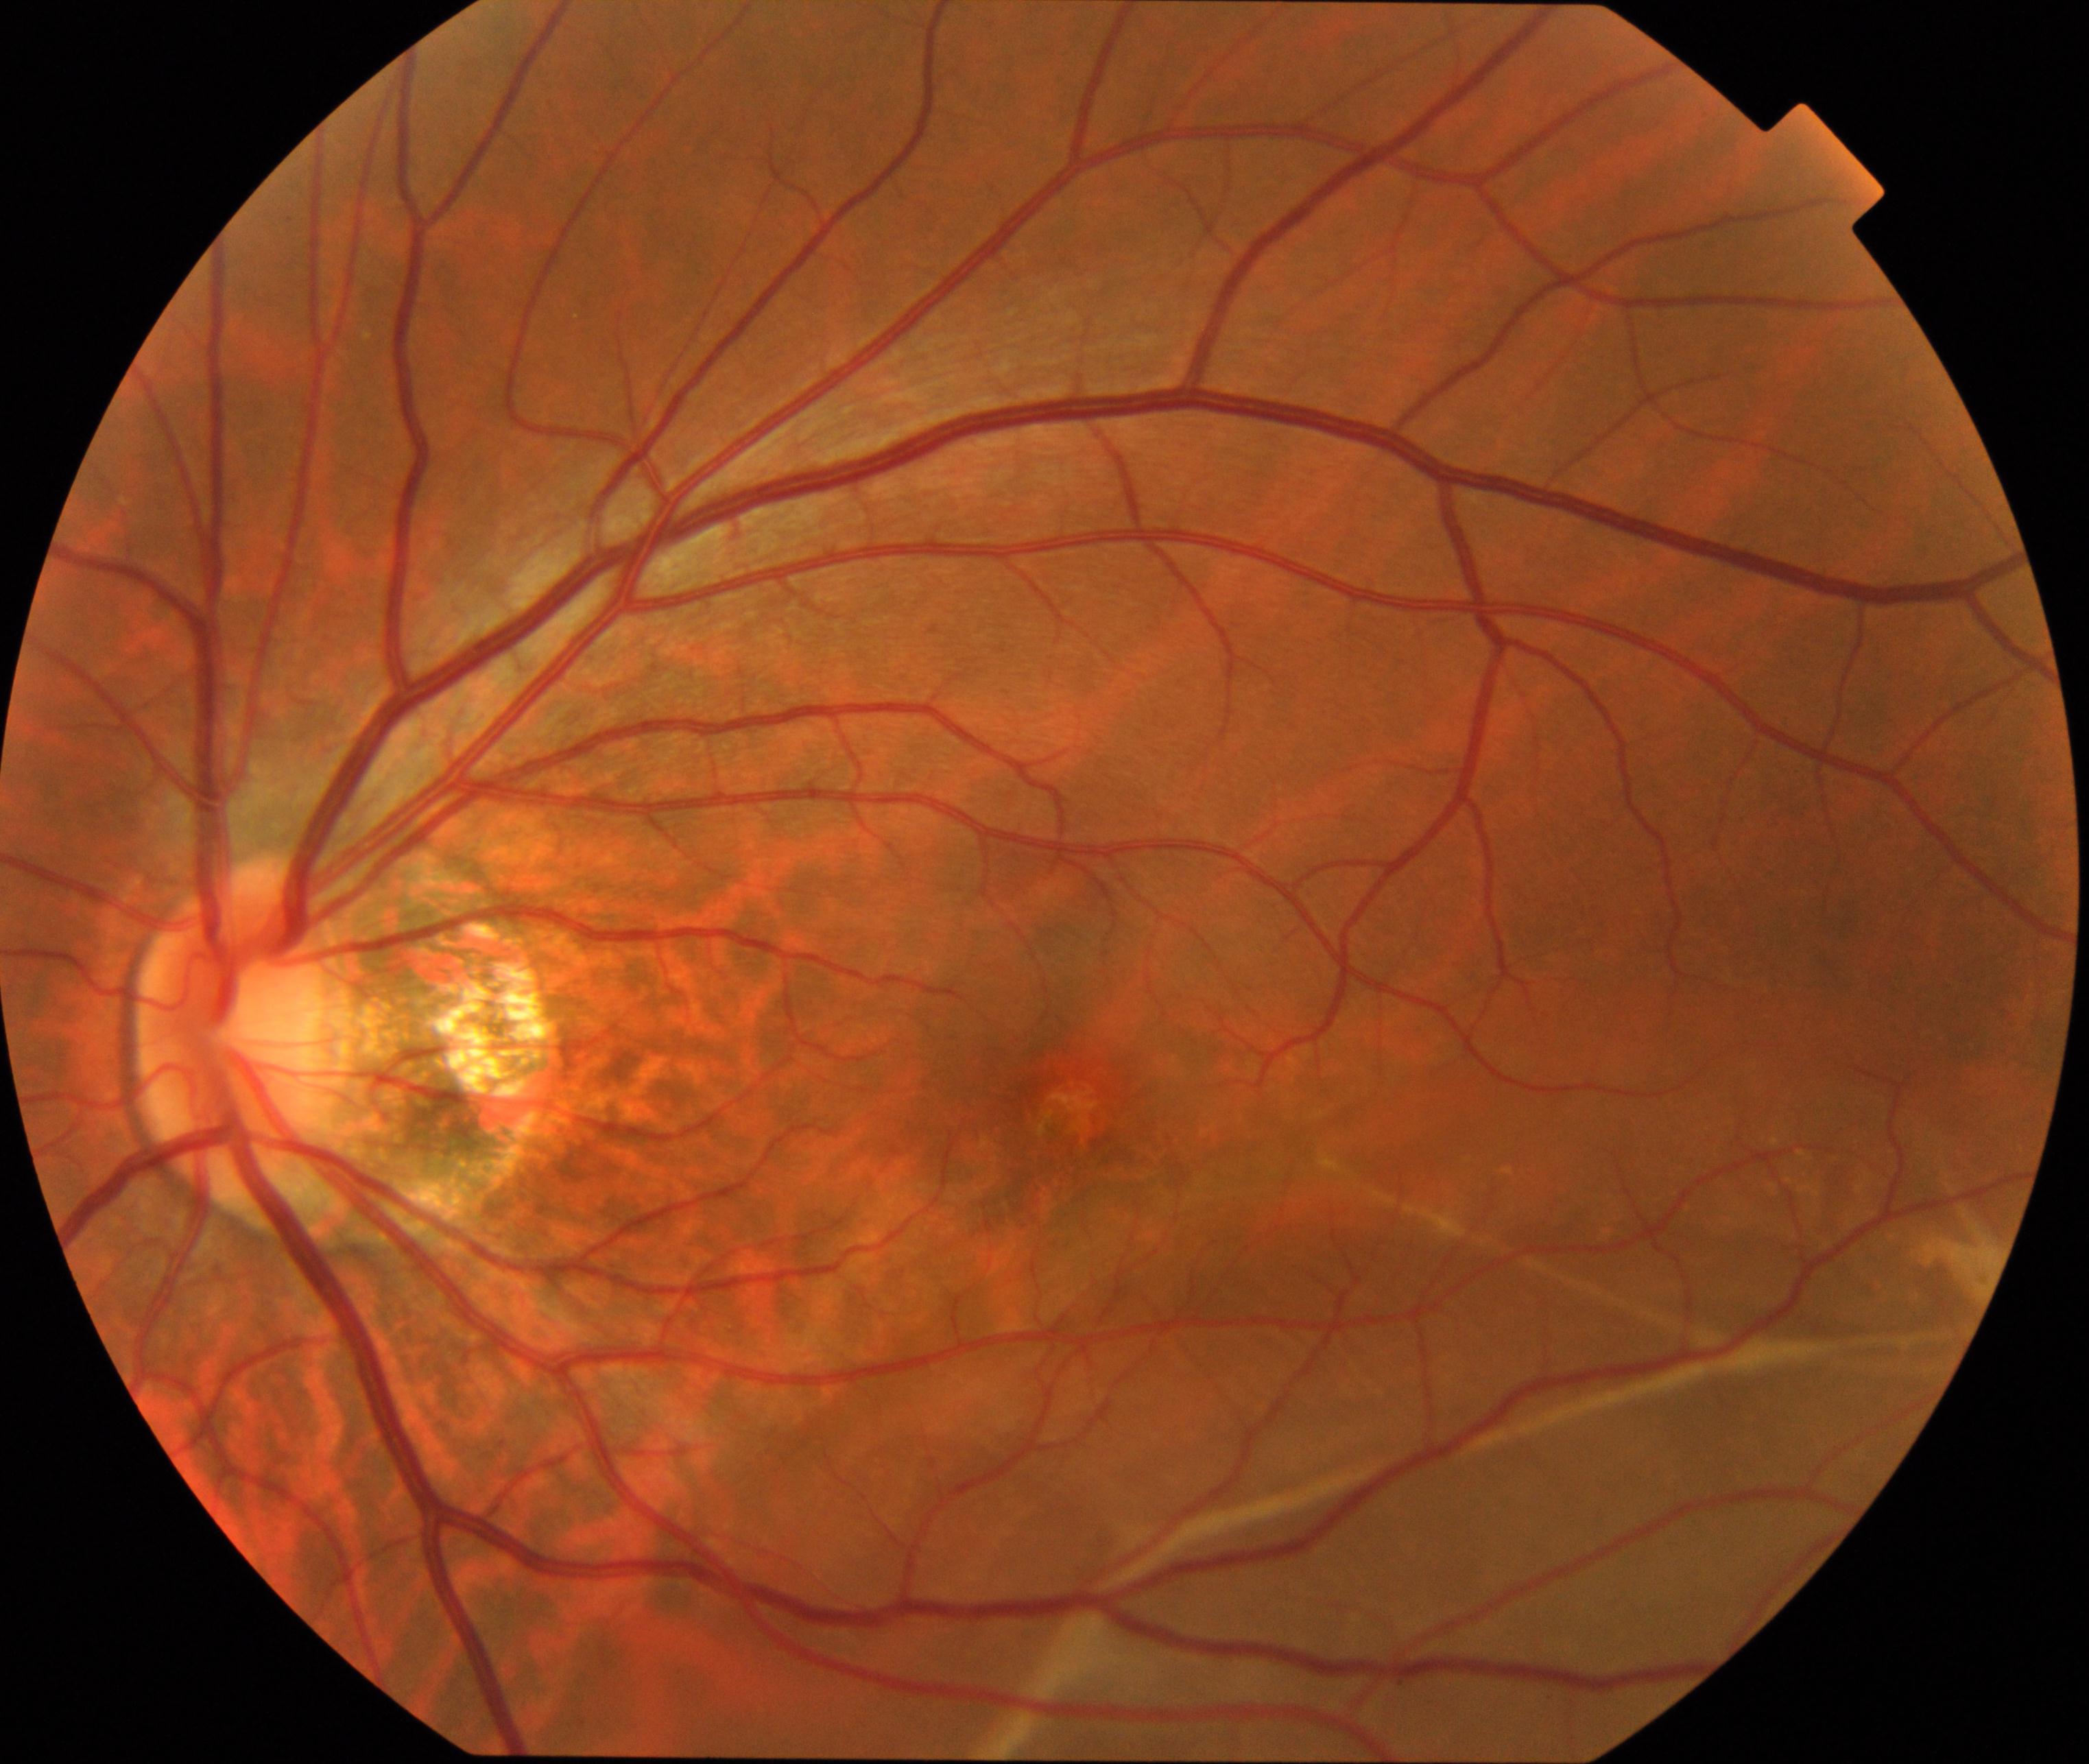

Color fundus photograph showing rhegmatogenous retinal detachment.